RetCam wide-field infant fundus image — 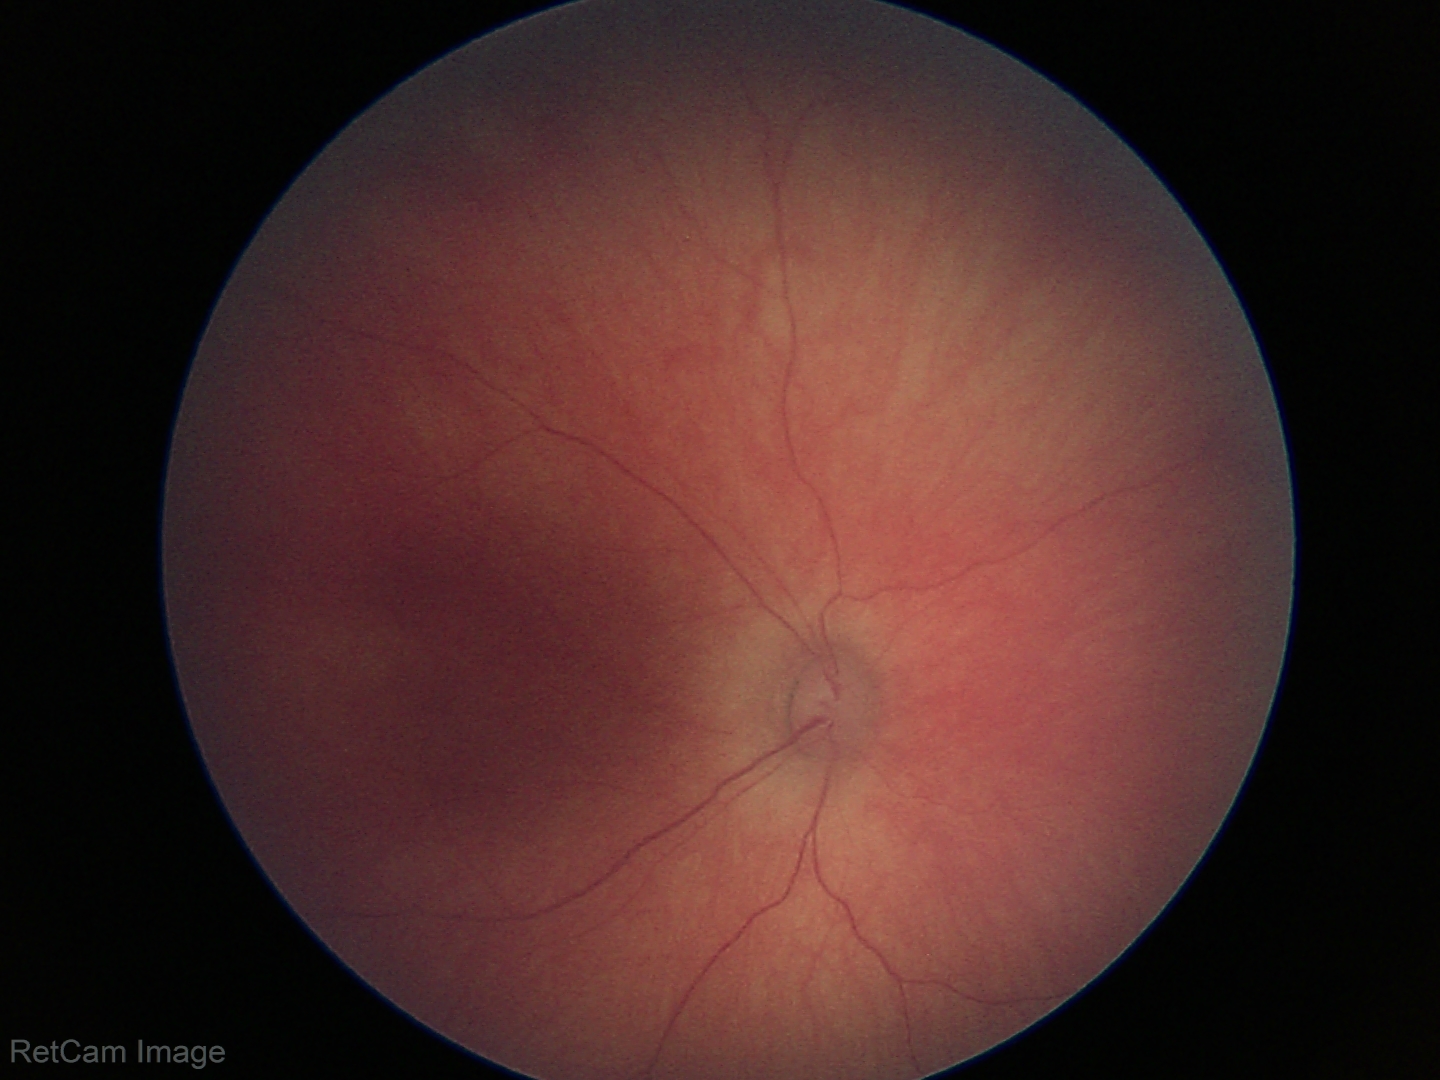
No retinal pathology identified on screening.